240x240px: 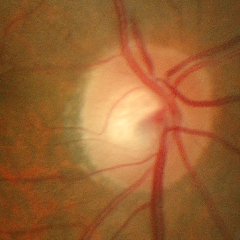 Fundus appearance consistent with early glaucoma. Diagnostic criteria: glaucomatous retinal nerve fiber layer defects on red-free fundus photography without visual field defects.